848 x 848 pixels, FOV: 45 degrees: 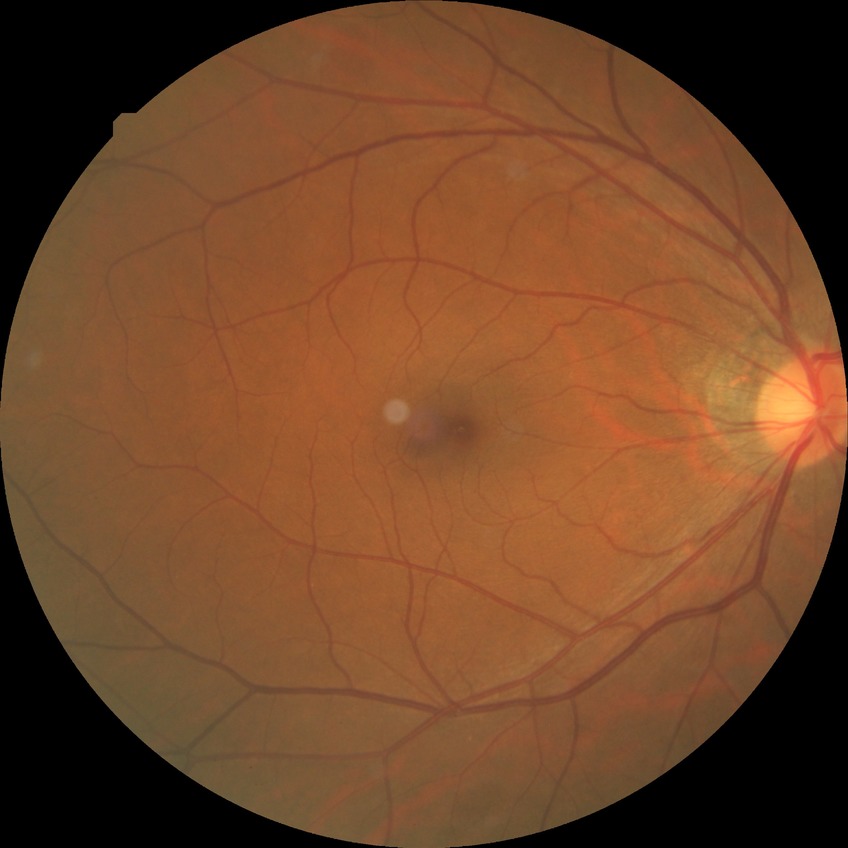

Findings:
- retinopathy grade: no diabetic retinopathy